1932x1916. 45° FOV. CFP: 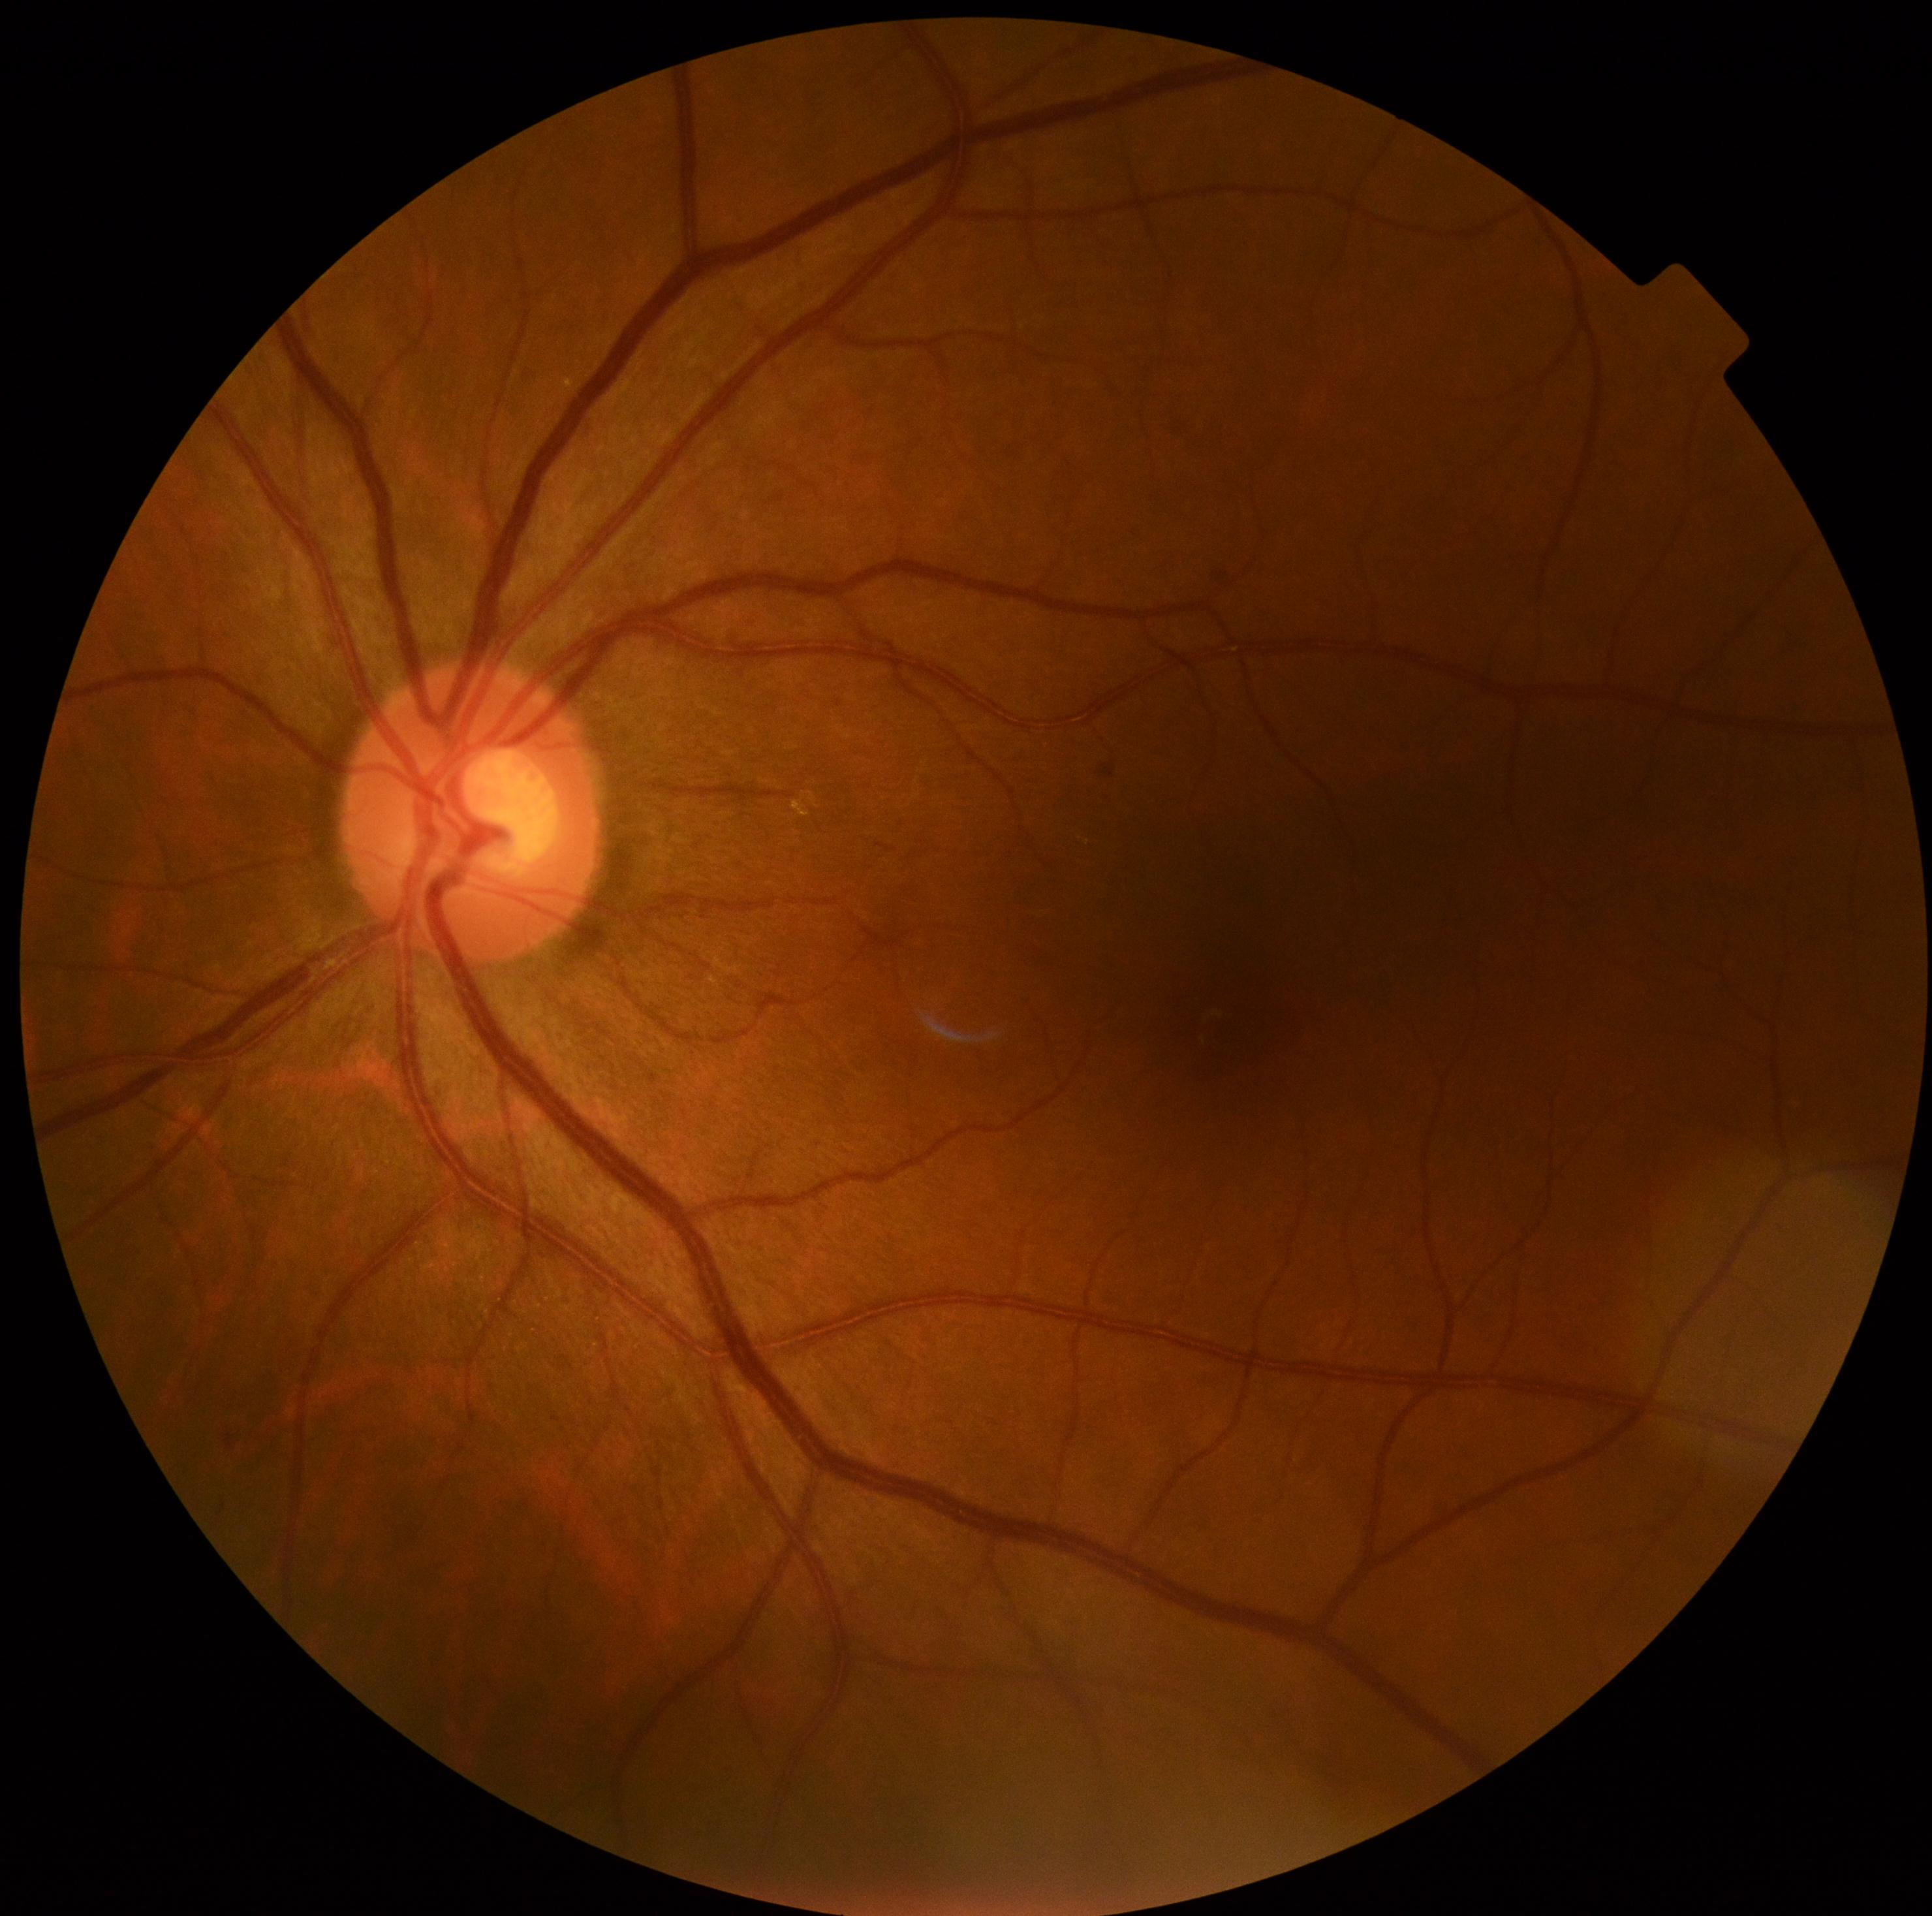

No apparent diabetic retinopathy. Retinopathy grade: 0/4.